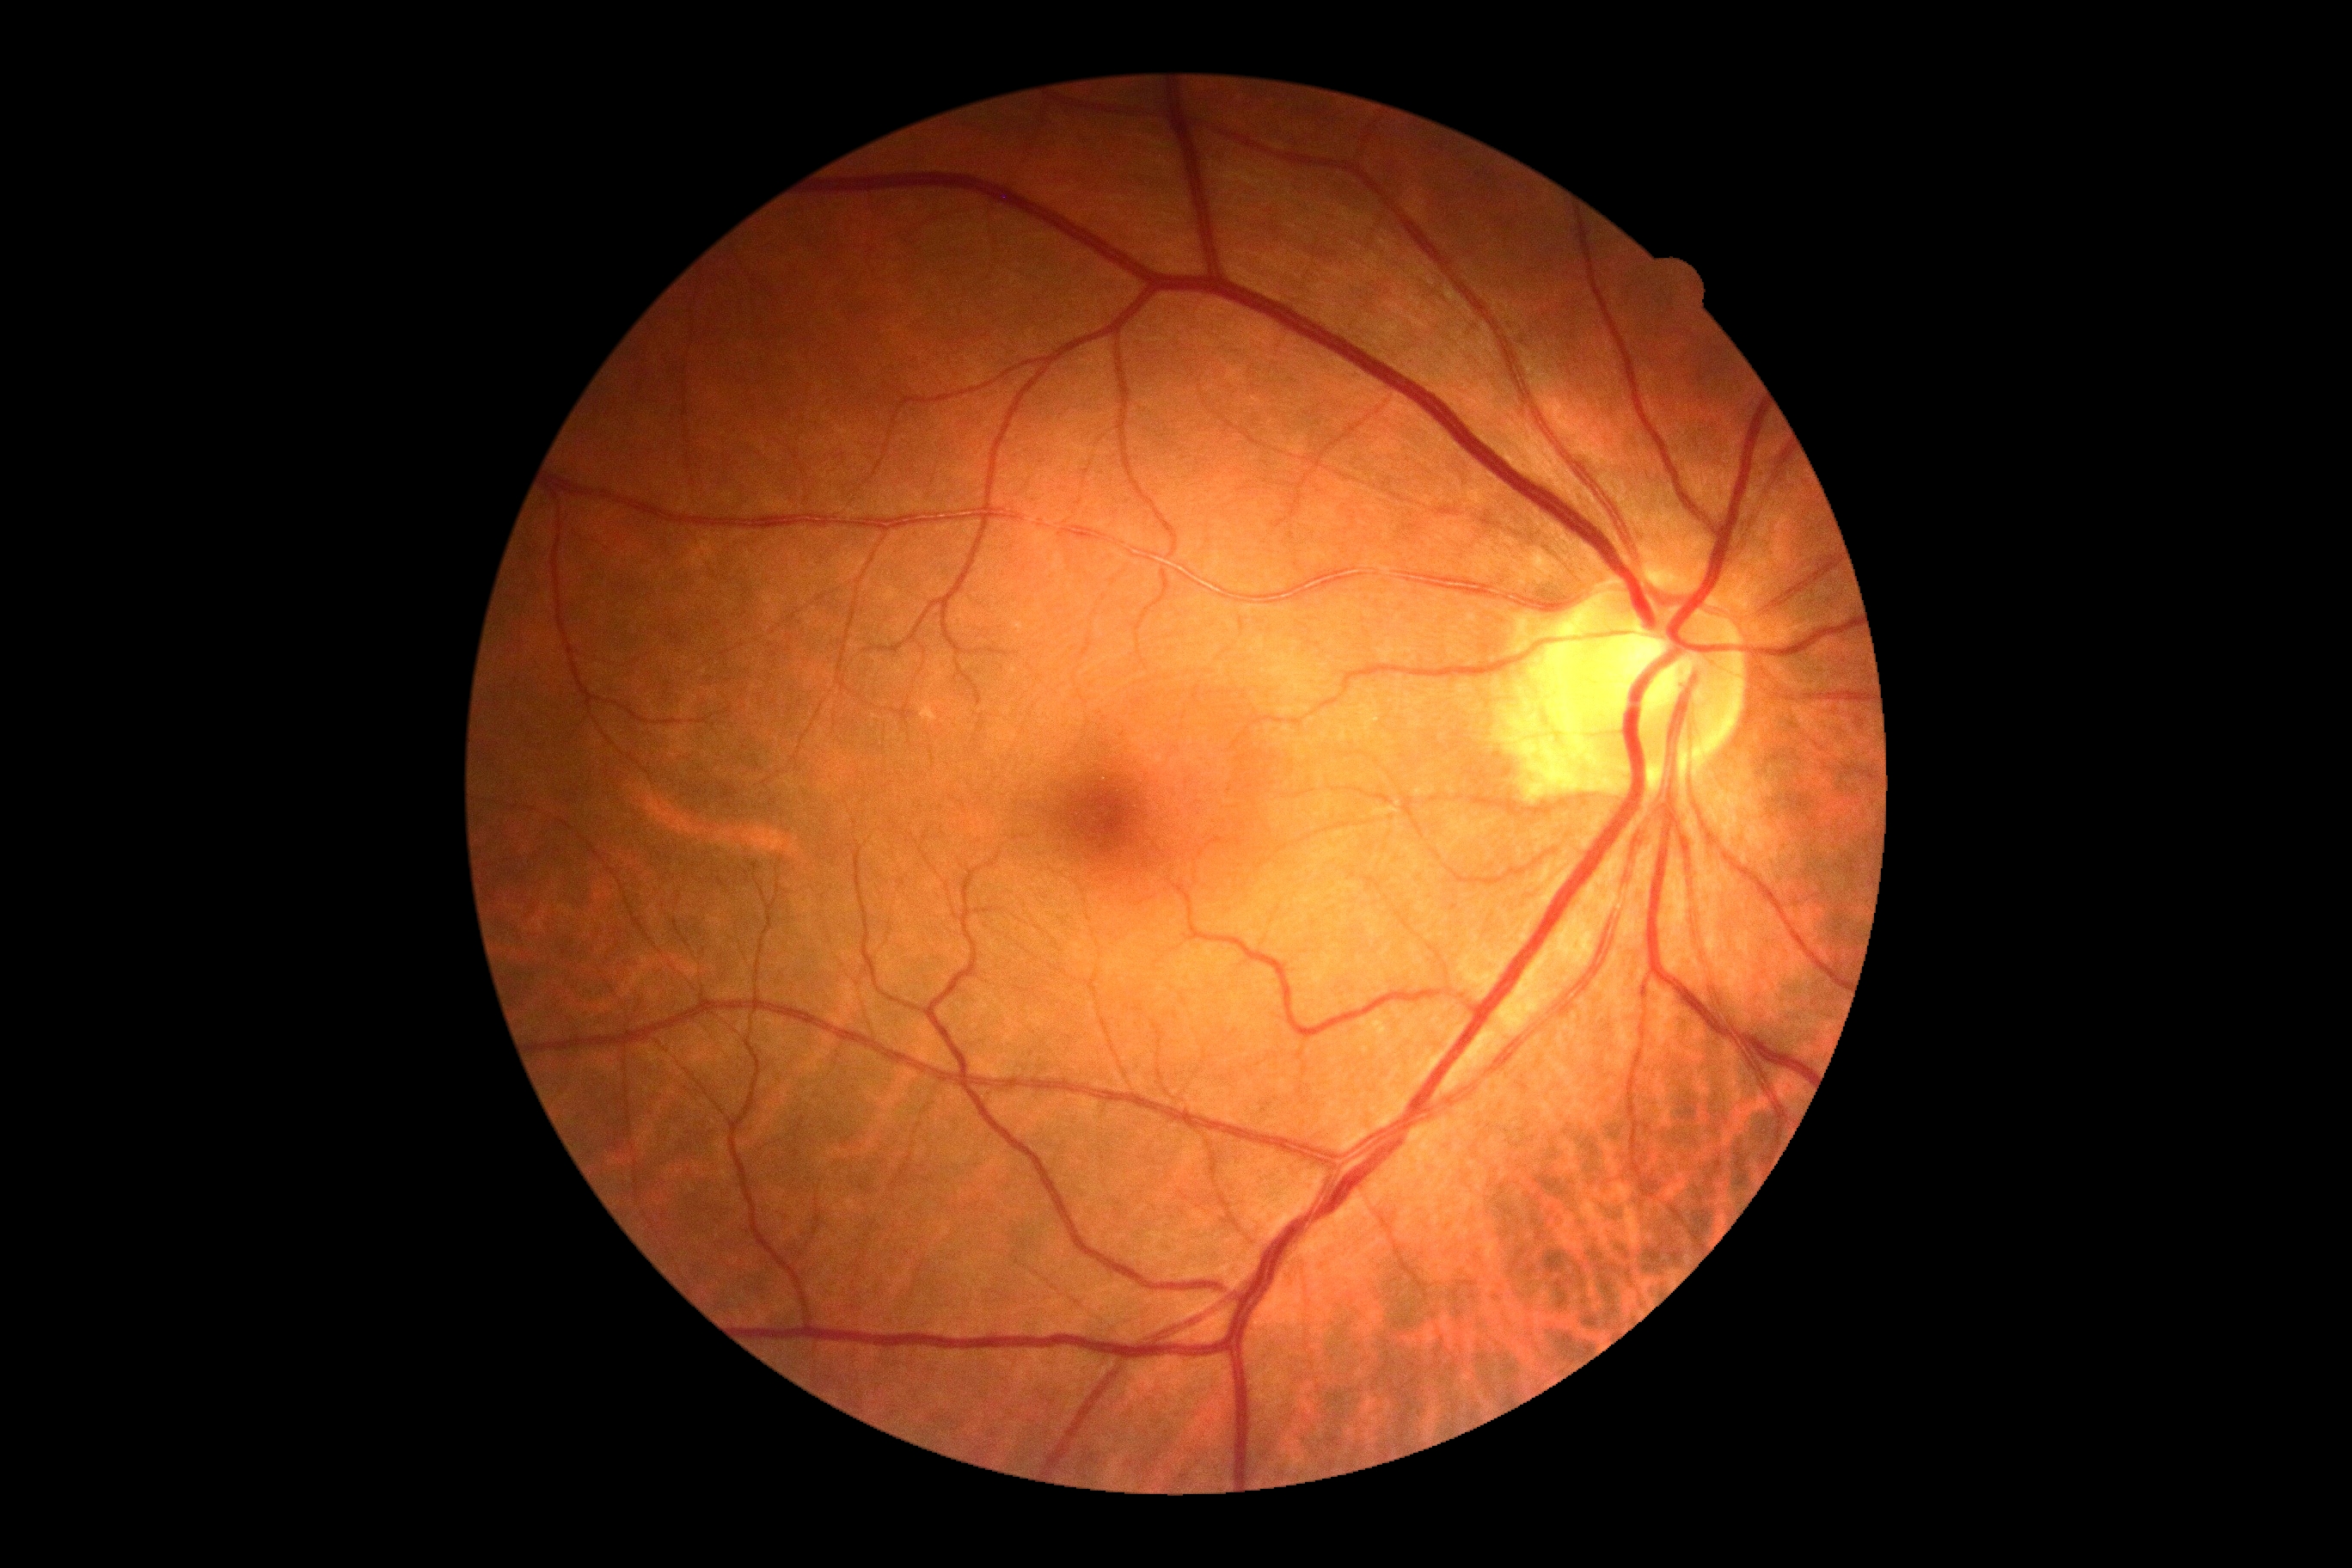 diabetic retinopathy (DR)@0.